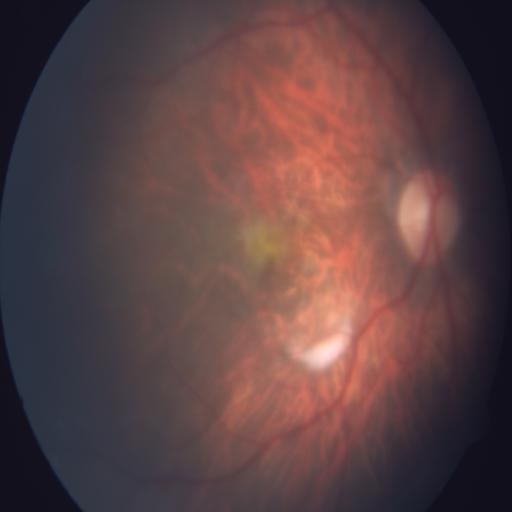

Three abnormalities. Showing tessellation (TSLN), myopia (MYA), and macular scar (MS).